Fundus photo. 2352x1568:
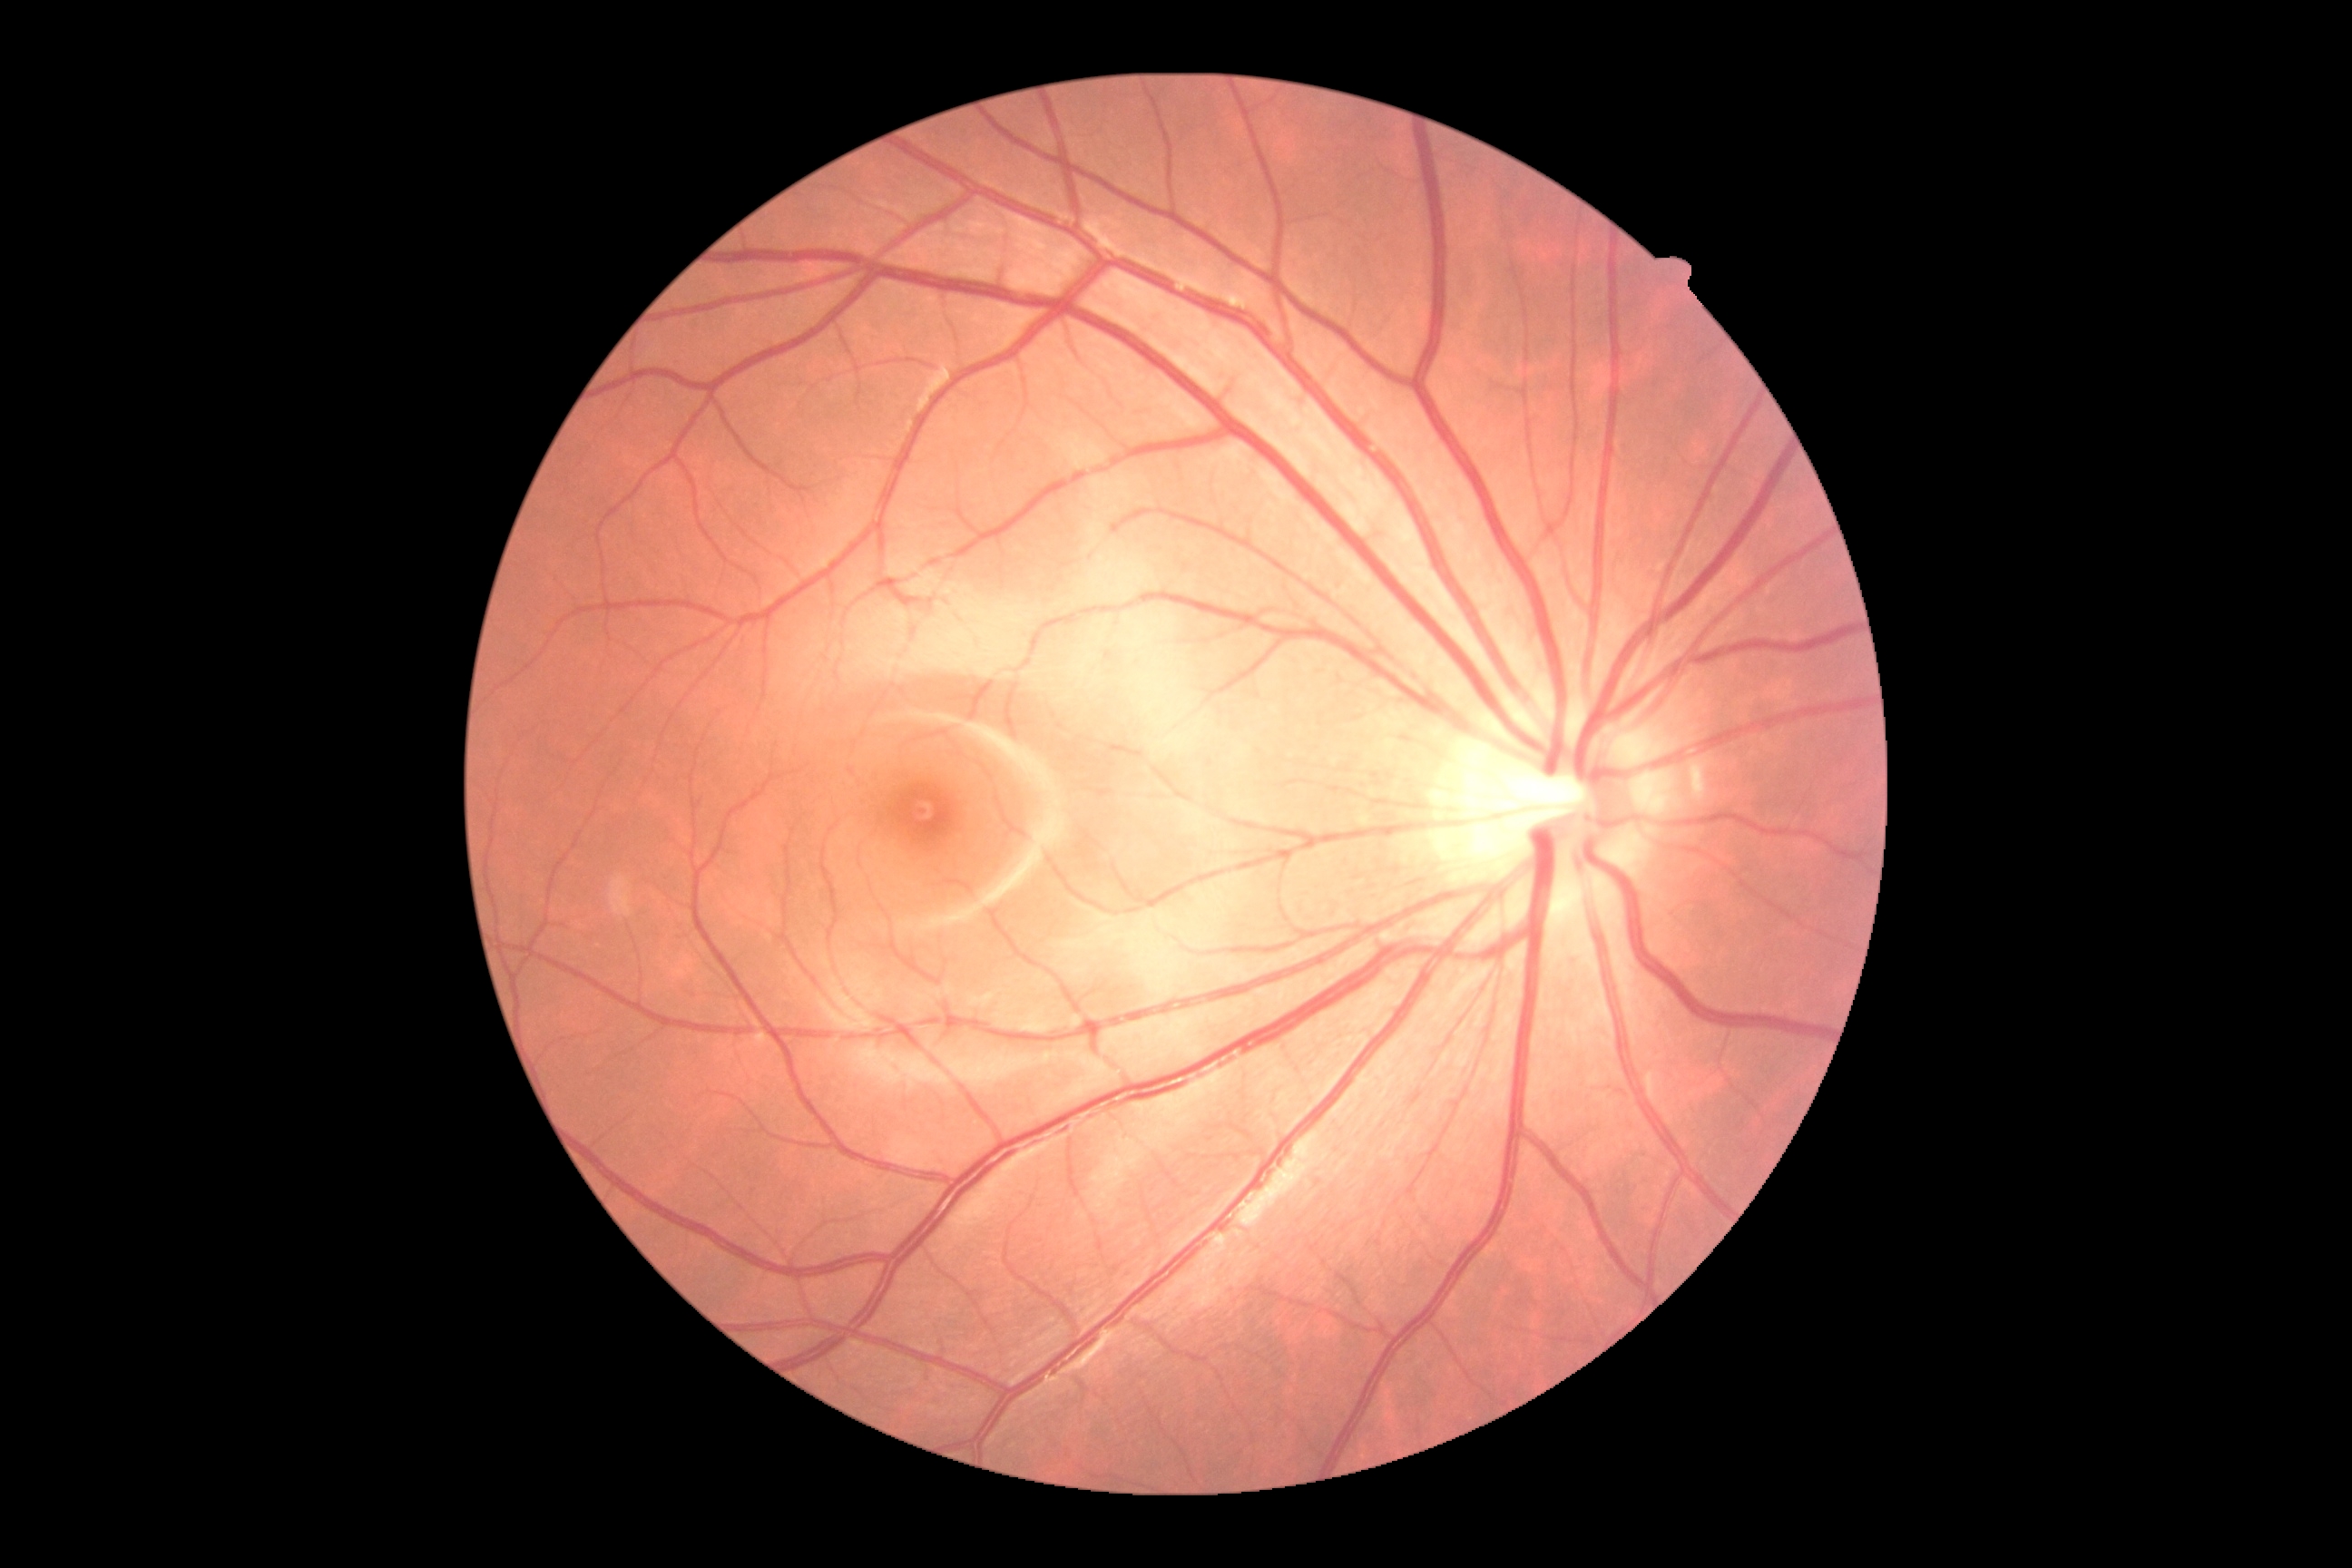
Diabetic retinopathy (DR) is grade 0 (no apparent retinopathy).